Wide-field fundus photograph from neonatal ROP screening
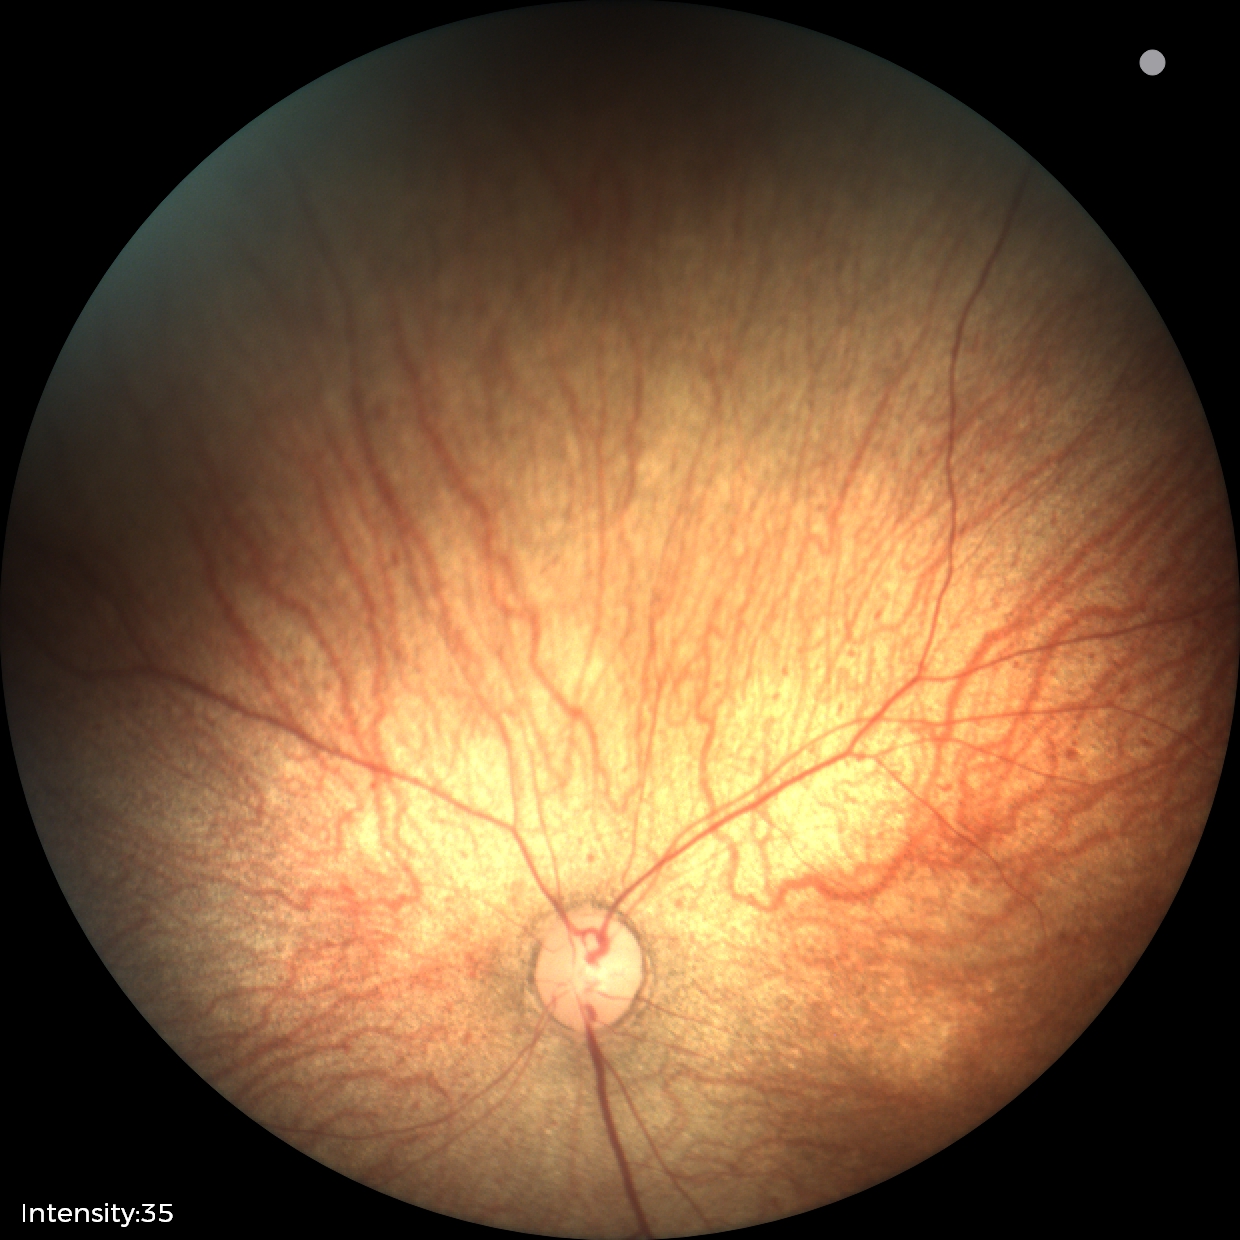
Physiological retinal appearance for postconceptual age.